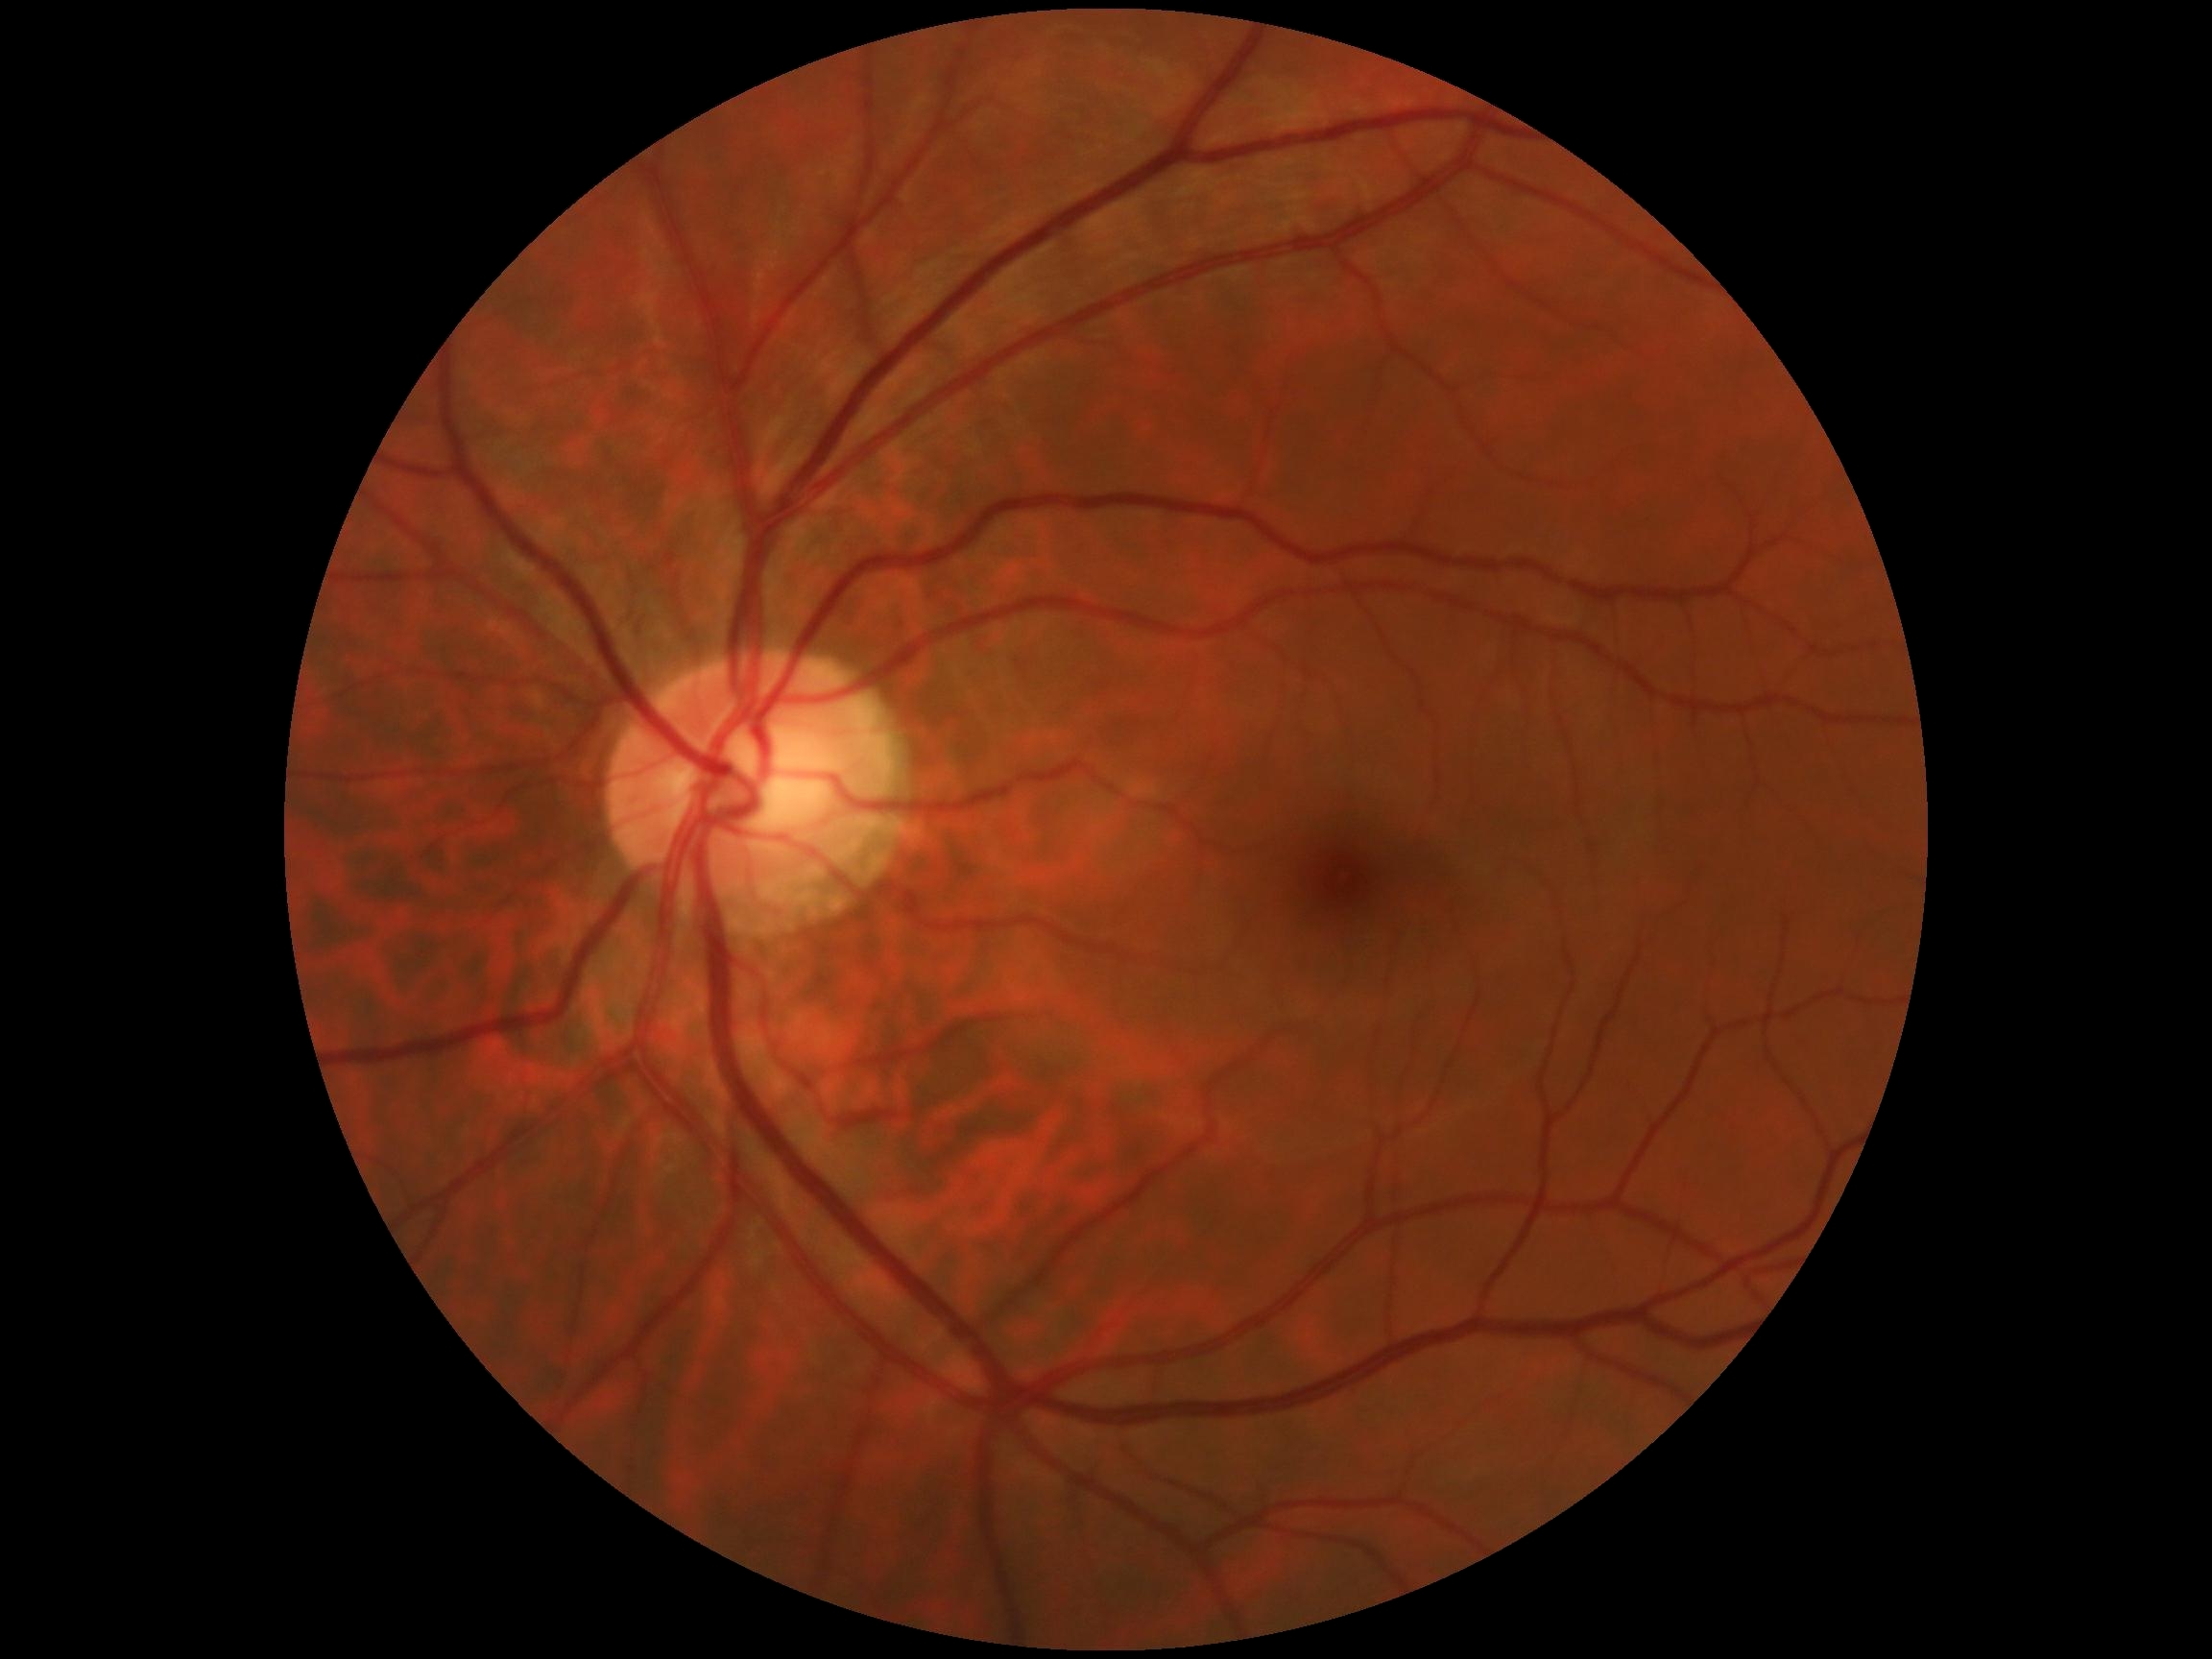 {"dr_grade": "0 (no apparent retinopathy)"}